2352 by 1568 pixels
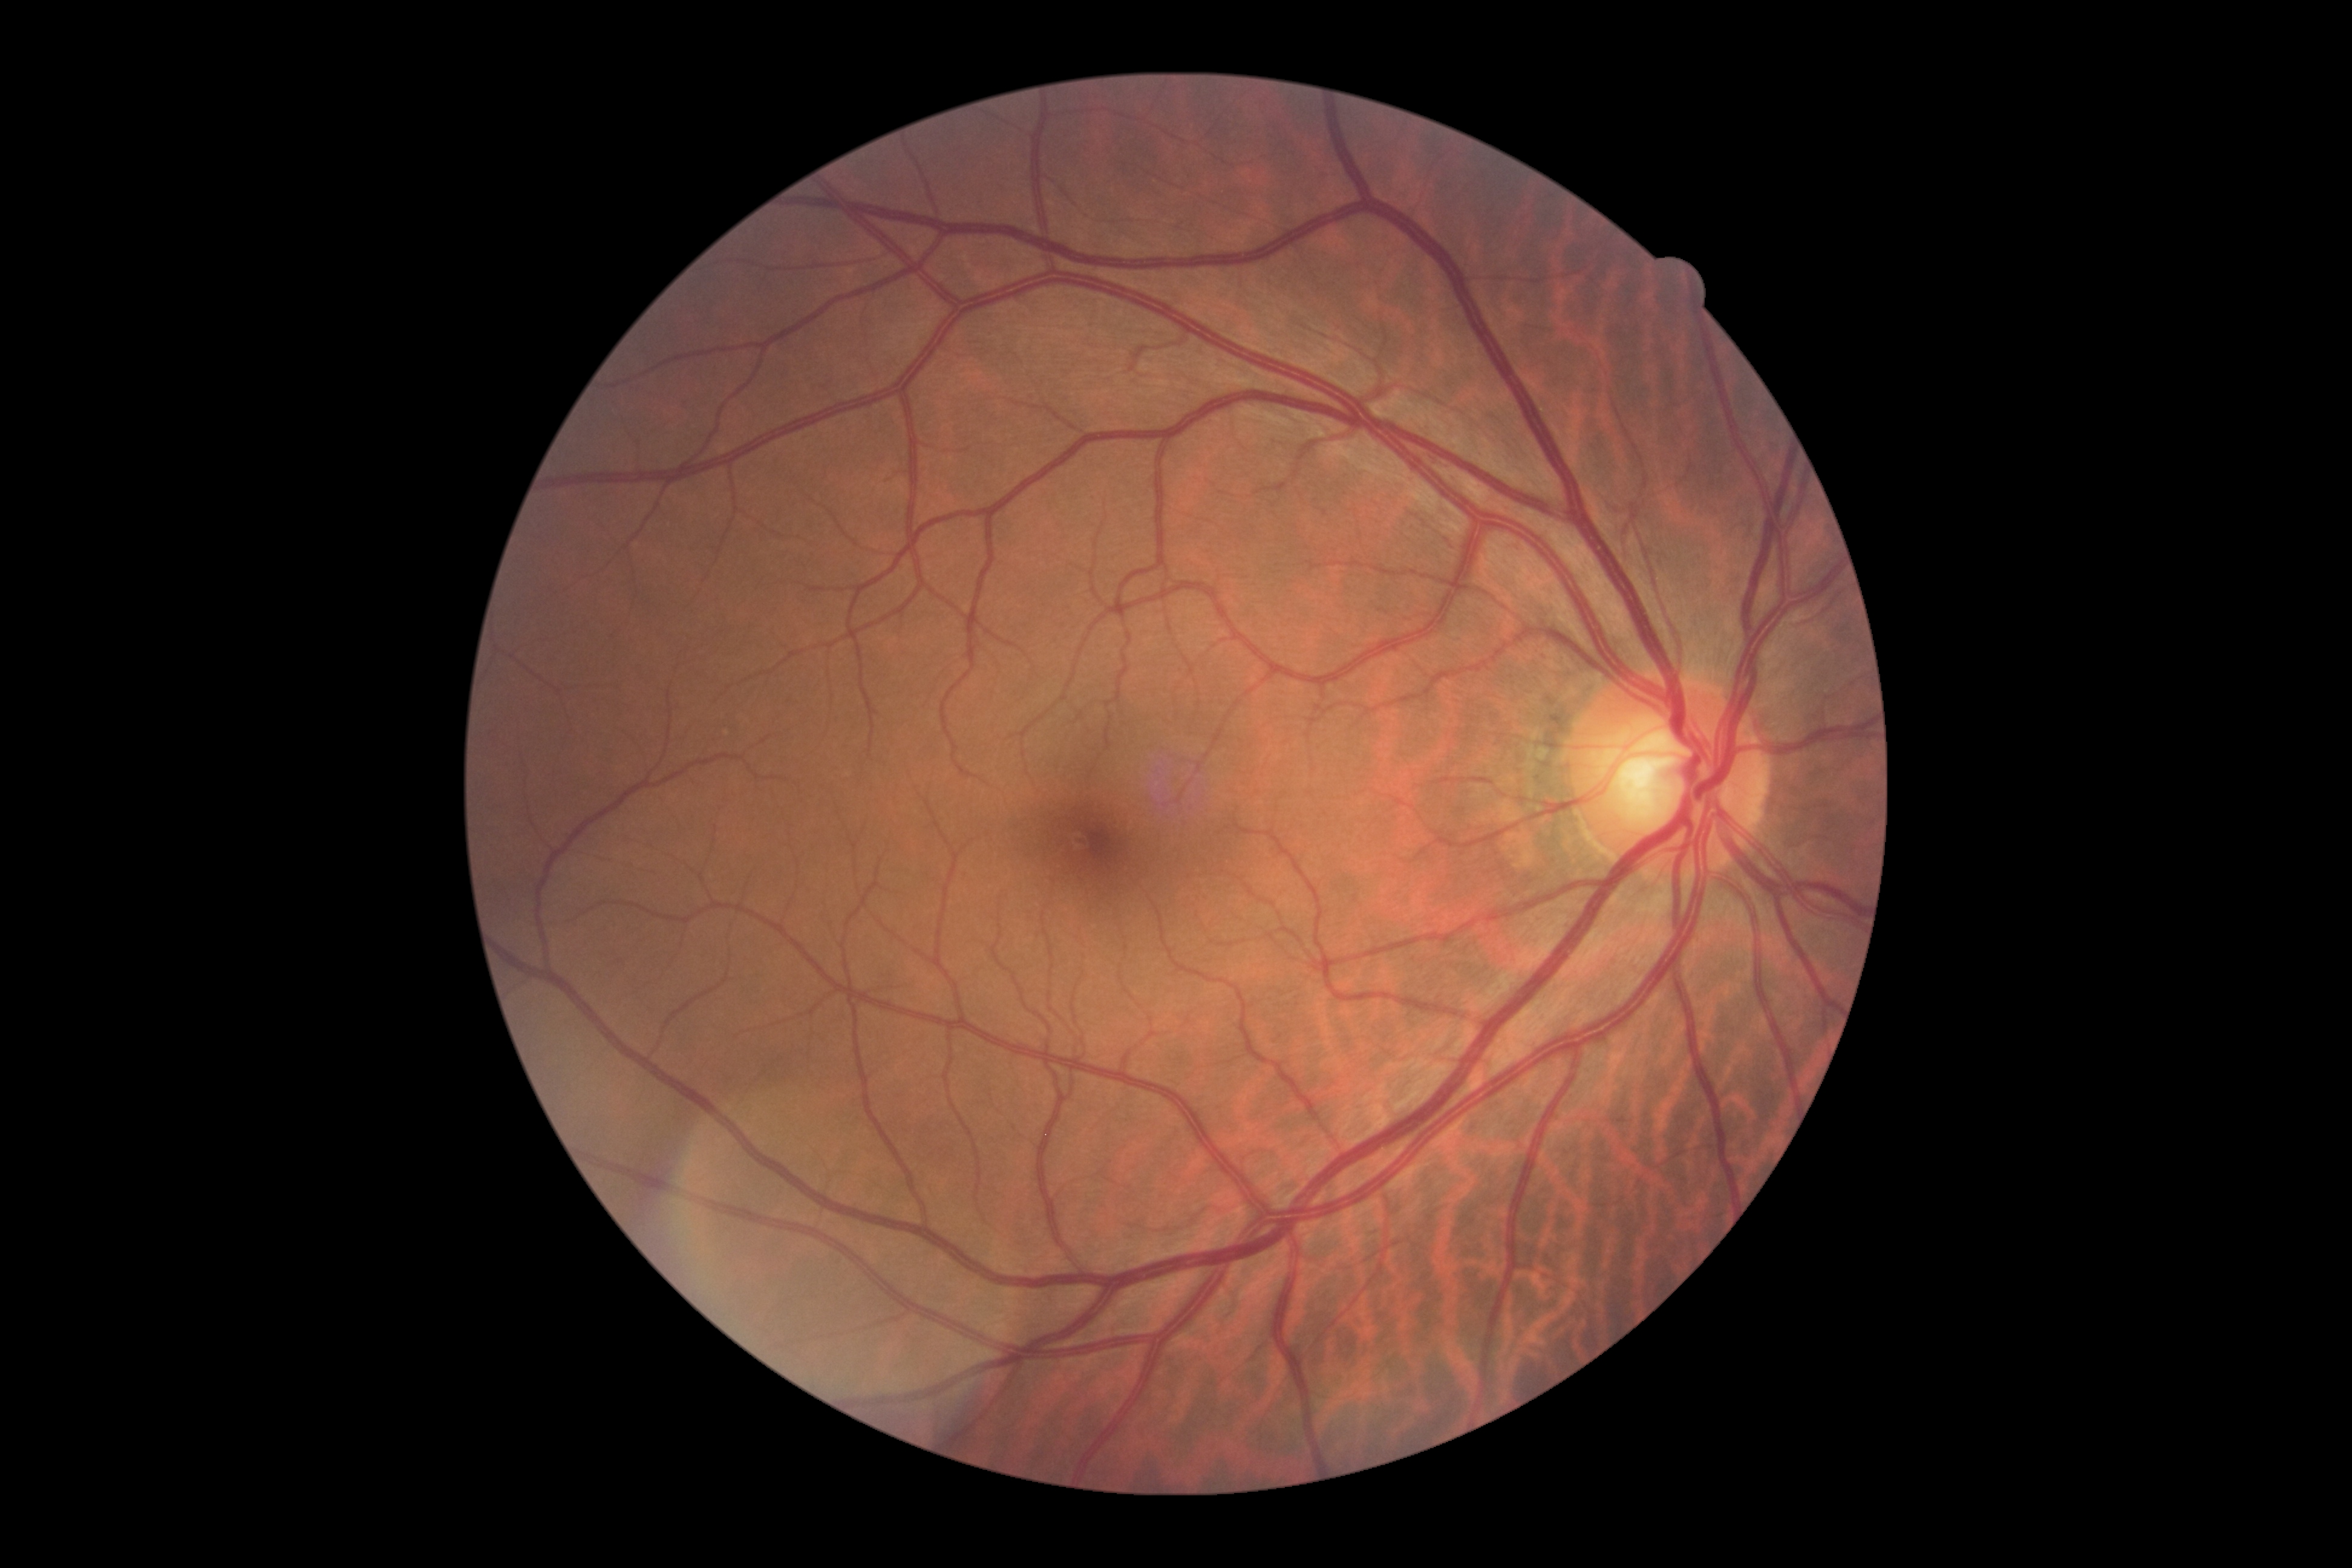 Findings:
- DR impression: no apparent DR
- DR: grade 0 (no apparent retinopathy)